512 x 512 pixels:
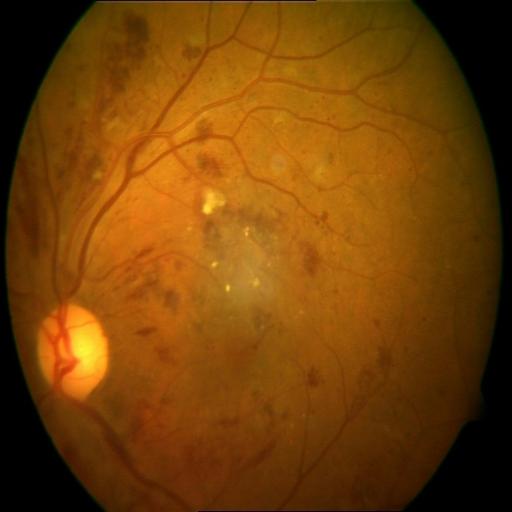 Fundus appearance consistent with hemorrhagic retinopathy.